Color fundus photograph.
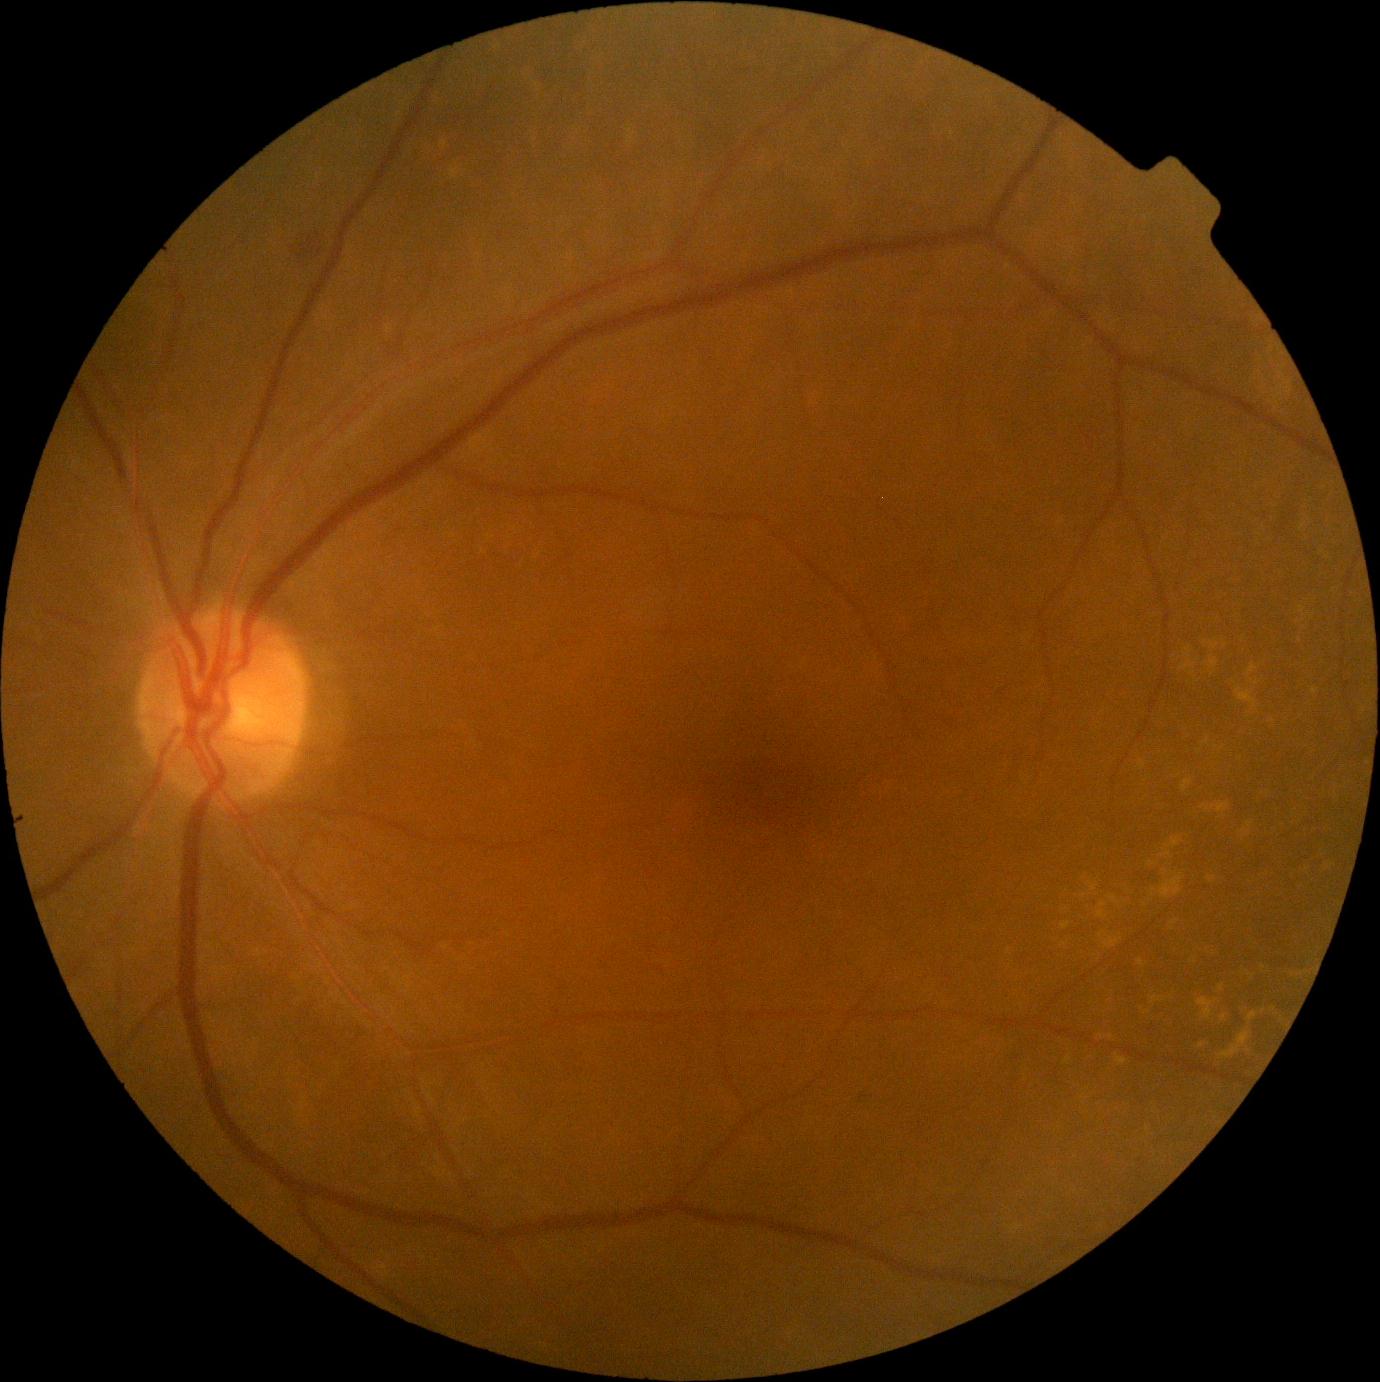 DR severity: 2/4.
No EXs identified.
HEs identified at 857/1092/875/1110.
No MAs identified.
No SEs identified.